Color fundus image; 45-degree field of view; 2352 by 1568 pixels.
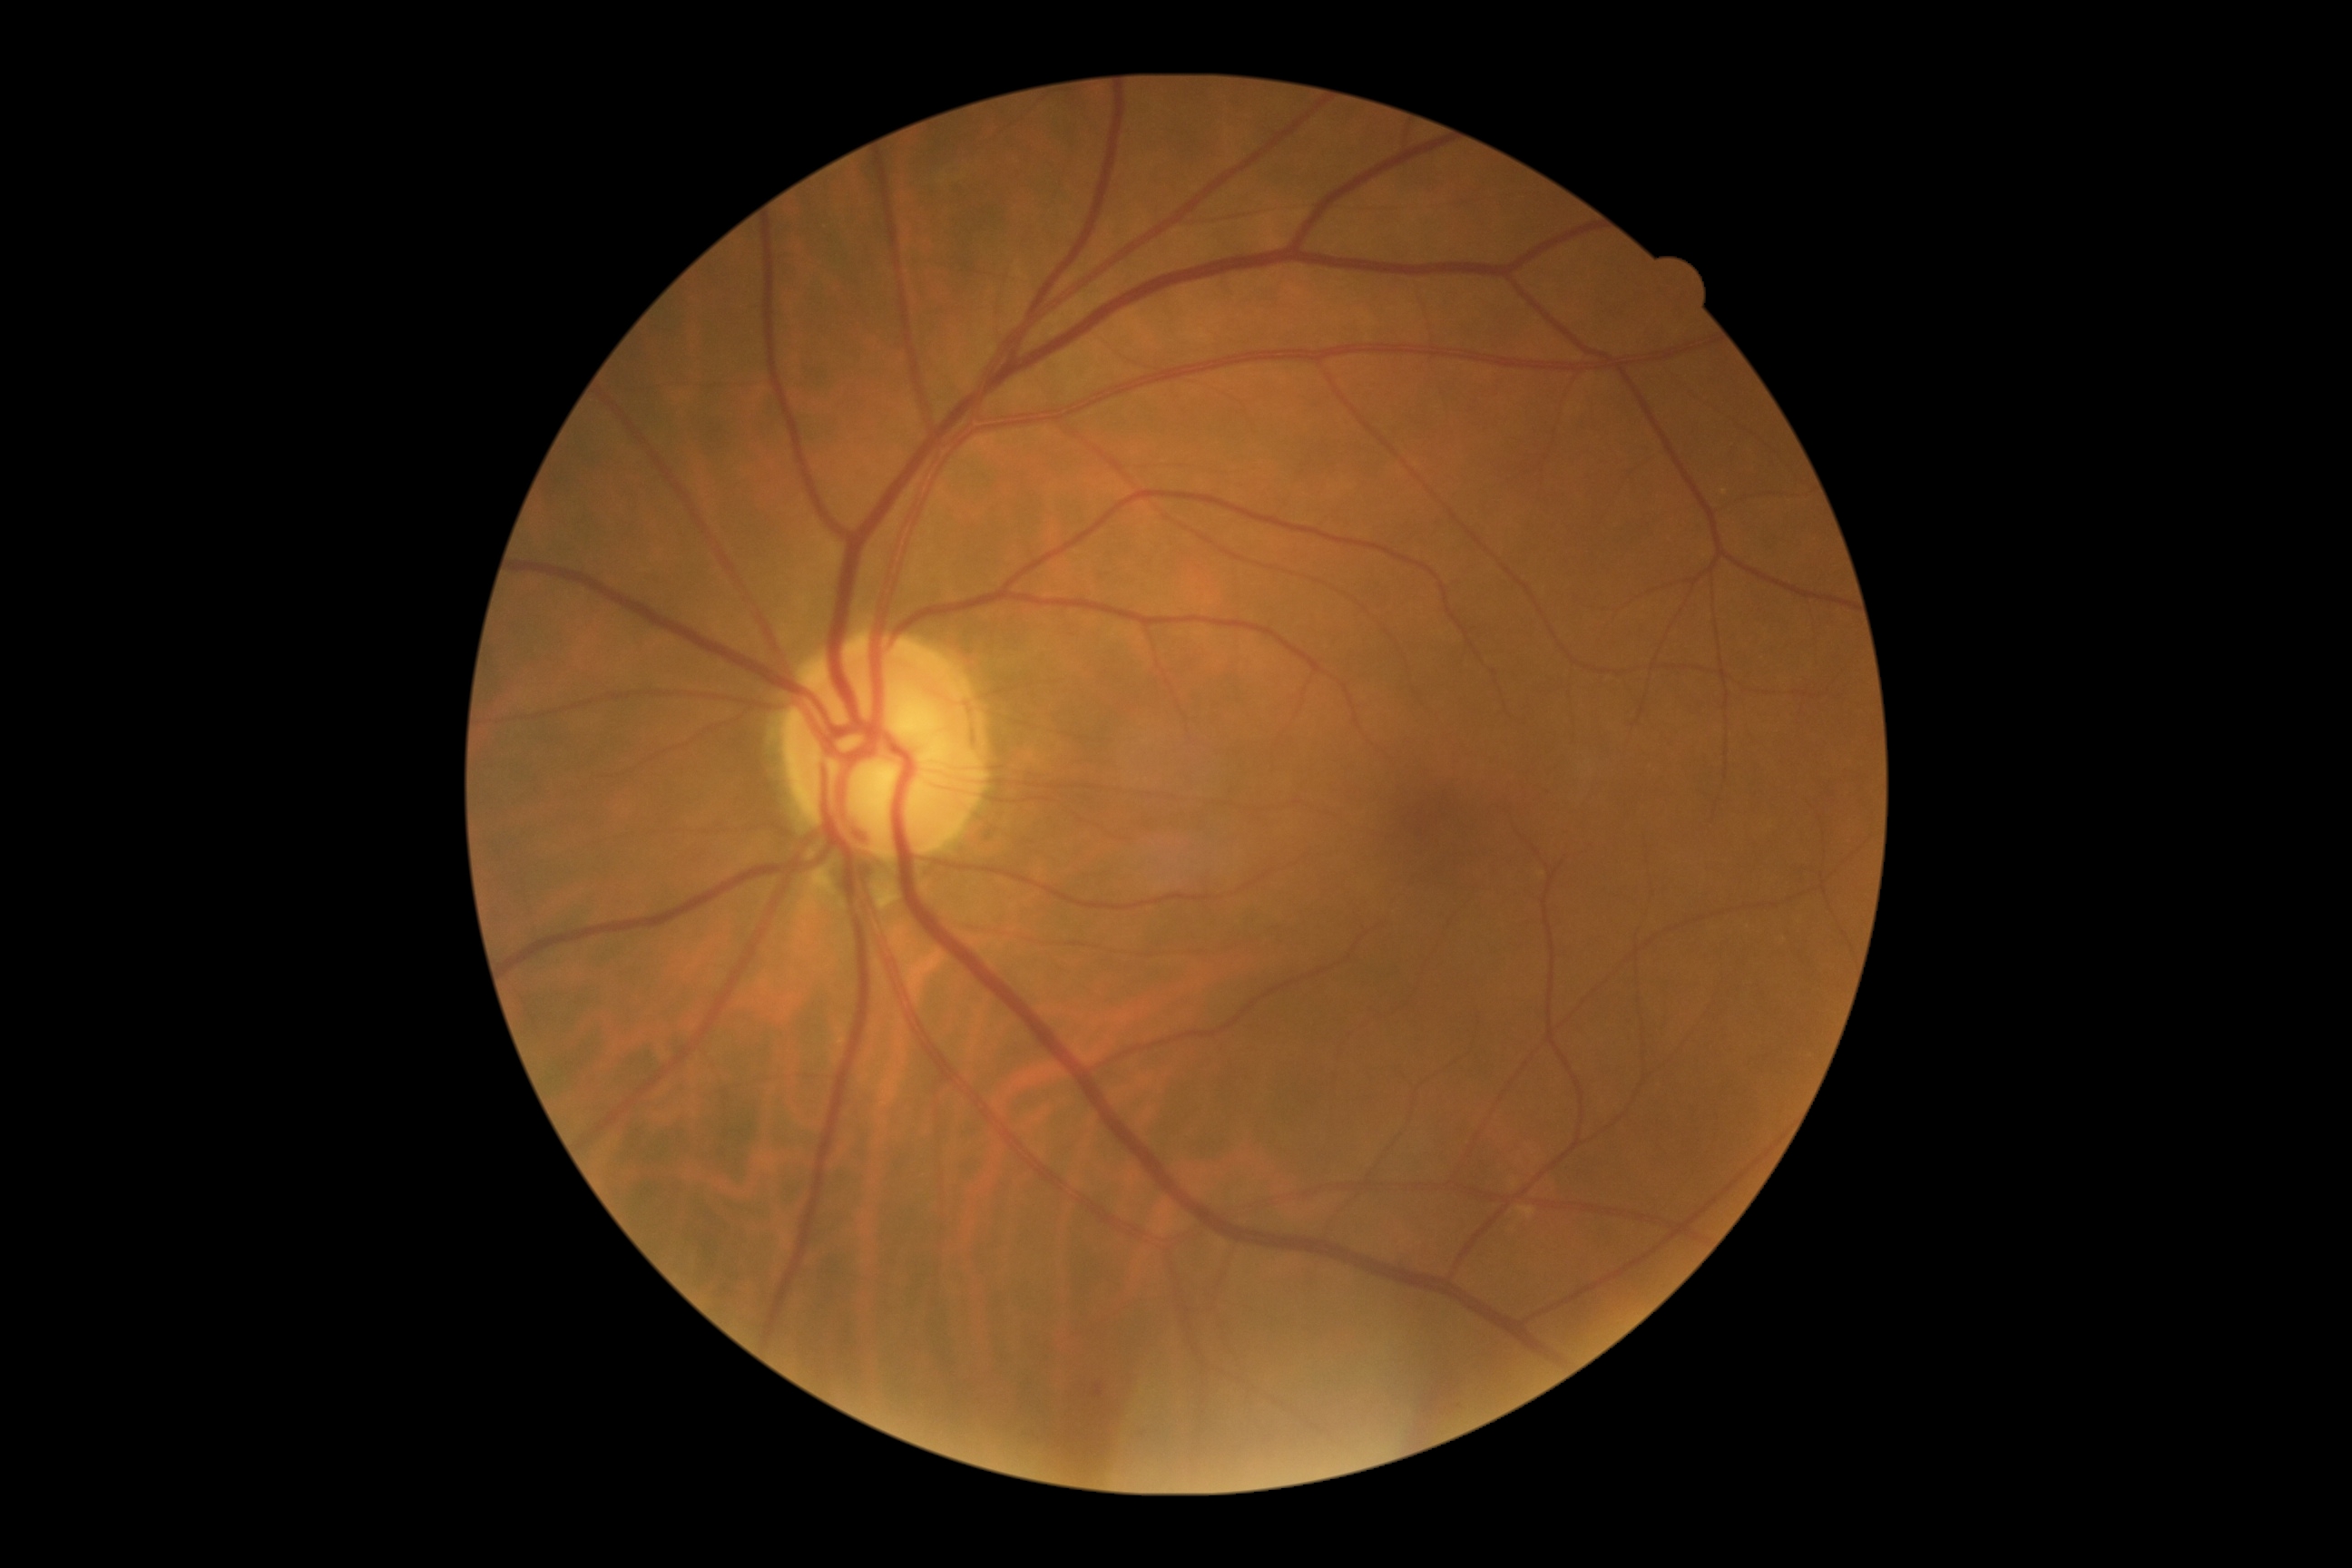 No signs of diabetic retinopathy.
Diabetic retinopathy (DR) is no apparent diabetic retinopathy (grade 0).